Modified Davis classification; no pharmacologic dilation; NIDEK AFC-230:
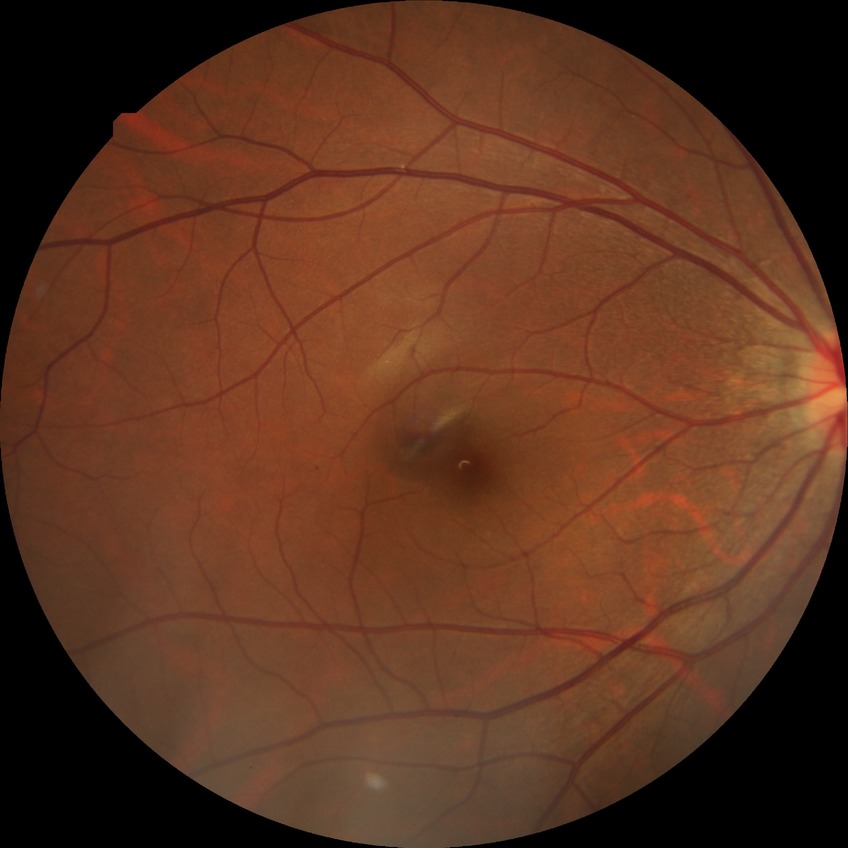

Diabetic retinopathy severity: no diabetic retinopathy.